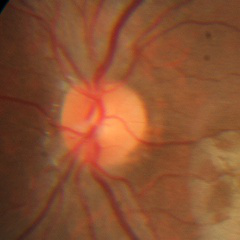
Optic disc photograph demonstrating no evidence of glaucoma.